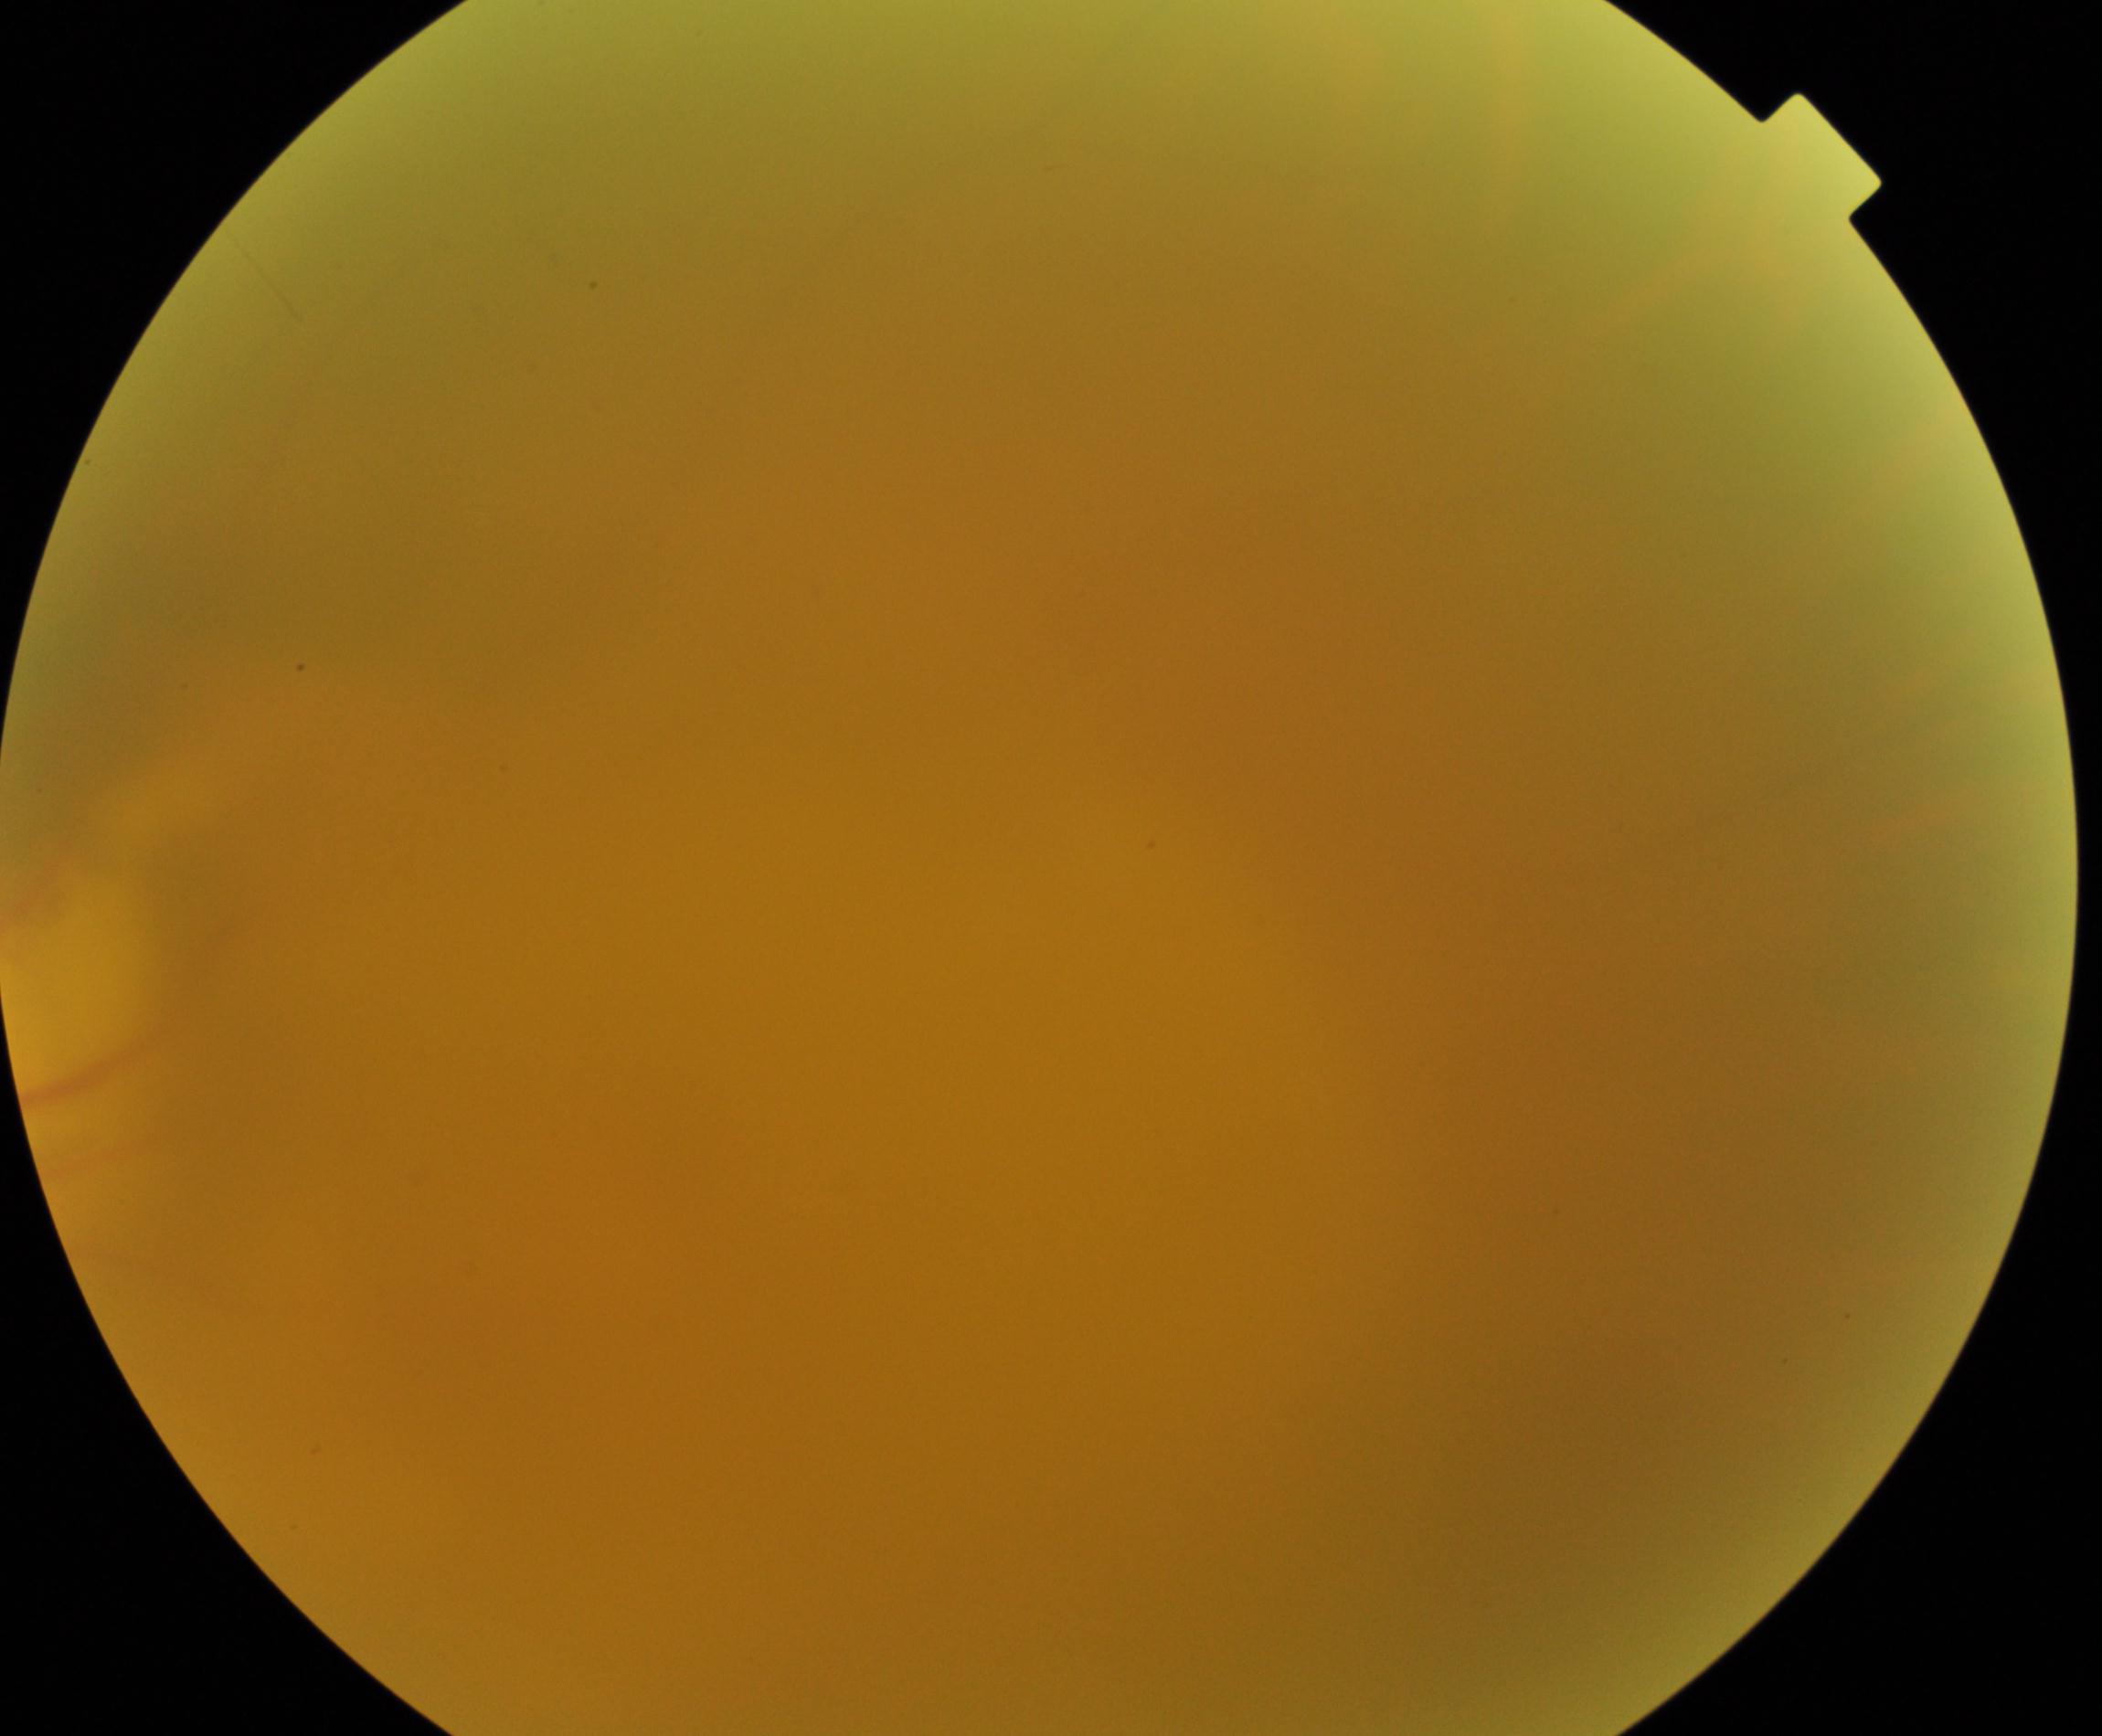
Image quality is poor; more than half the field is obscured. No evidence of proliferative diabetic retinopathy.